Infant wide-field retinal image · 1240 by 1240 pixels · 100° field of view (Phoenix ICON).
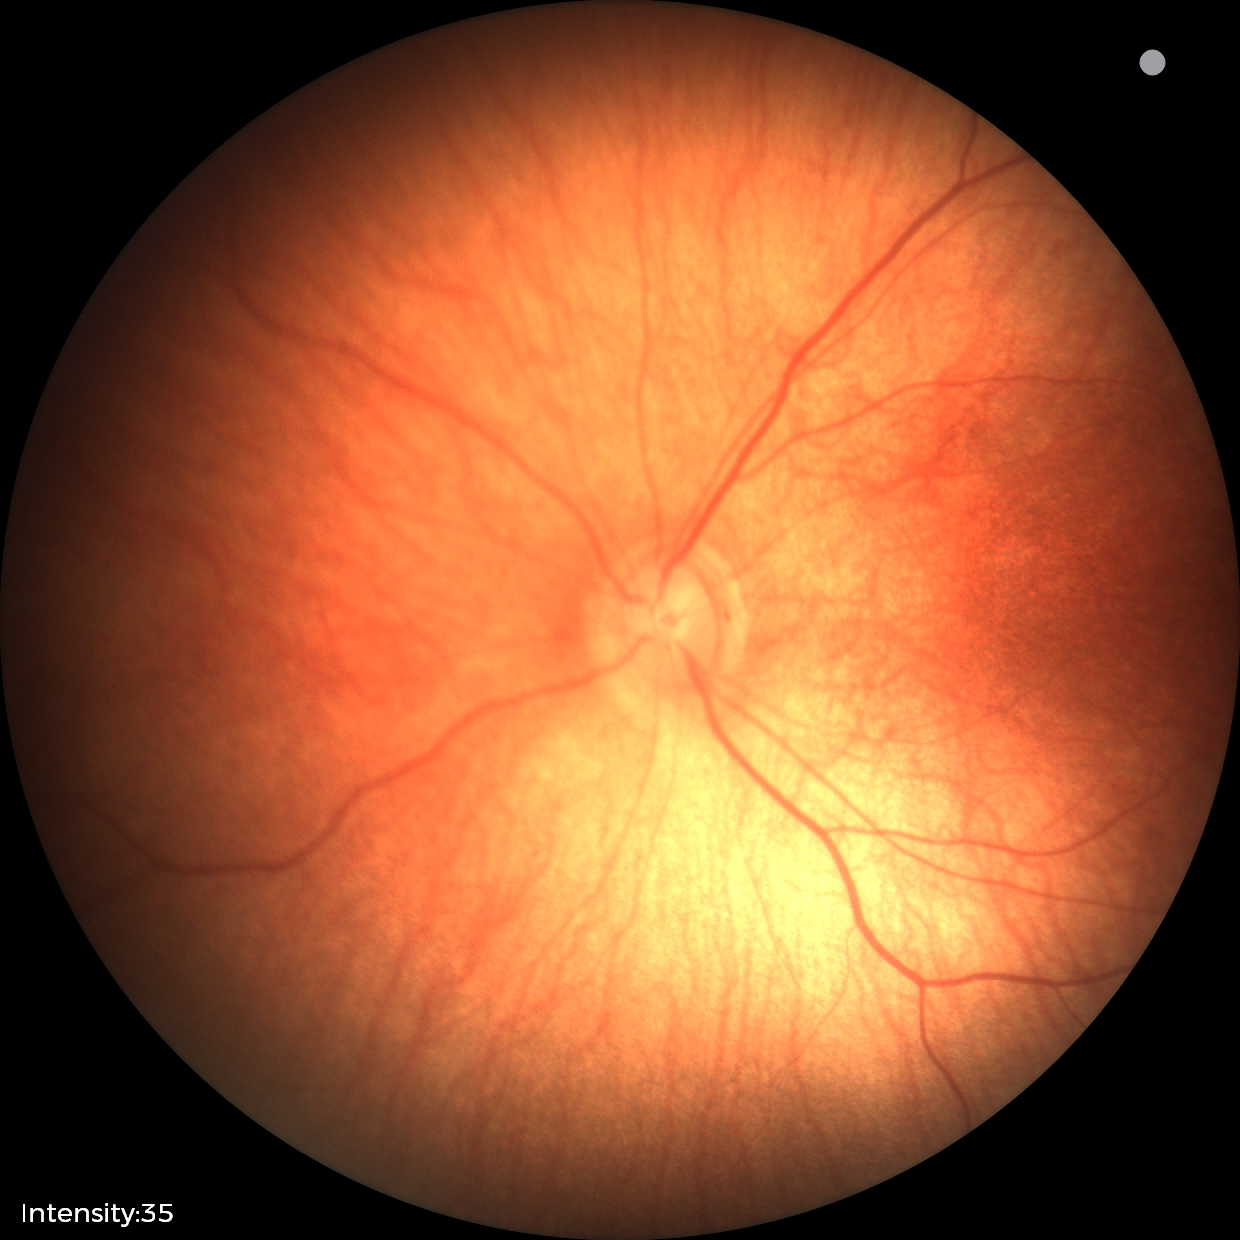 Diagnosis = no pathology identified